Color fundus photograph · modified Davis classification · nonmydriatic · 848x848px · FOV: 45 degrees: 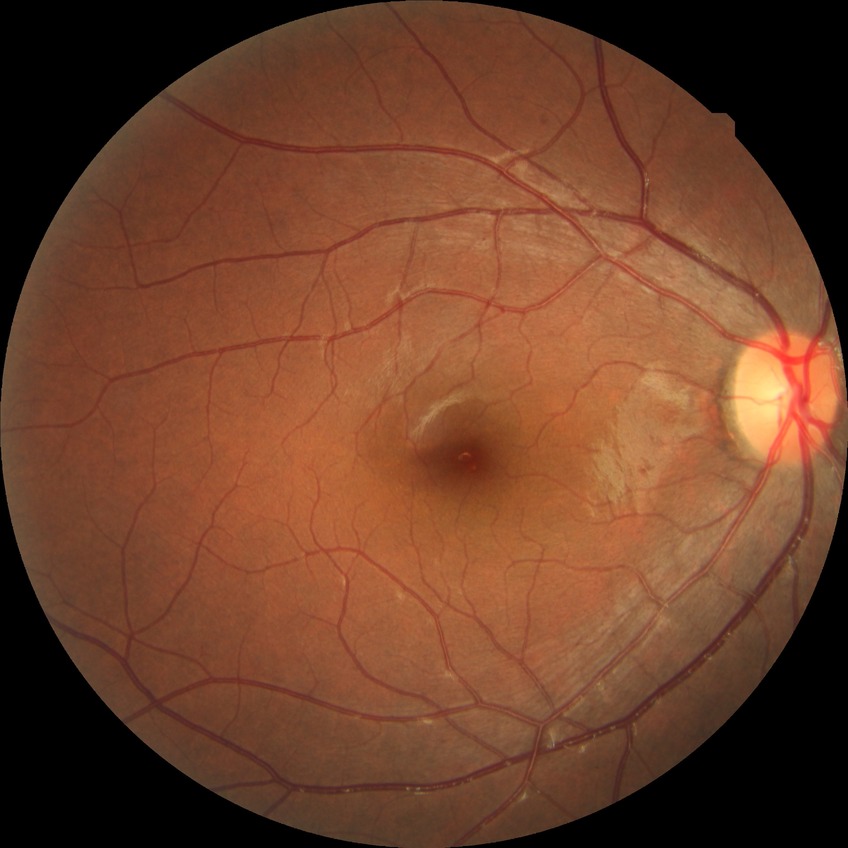

Diabetic retinopathy (DR) is no diabetic retinopathy (NDR).